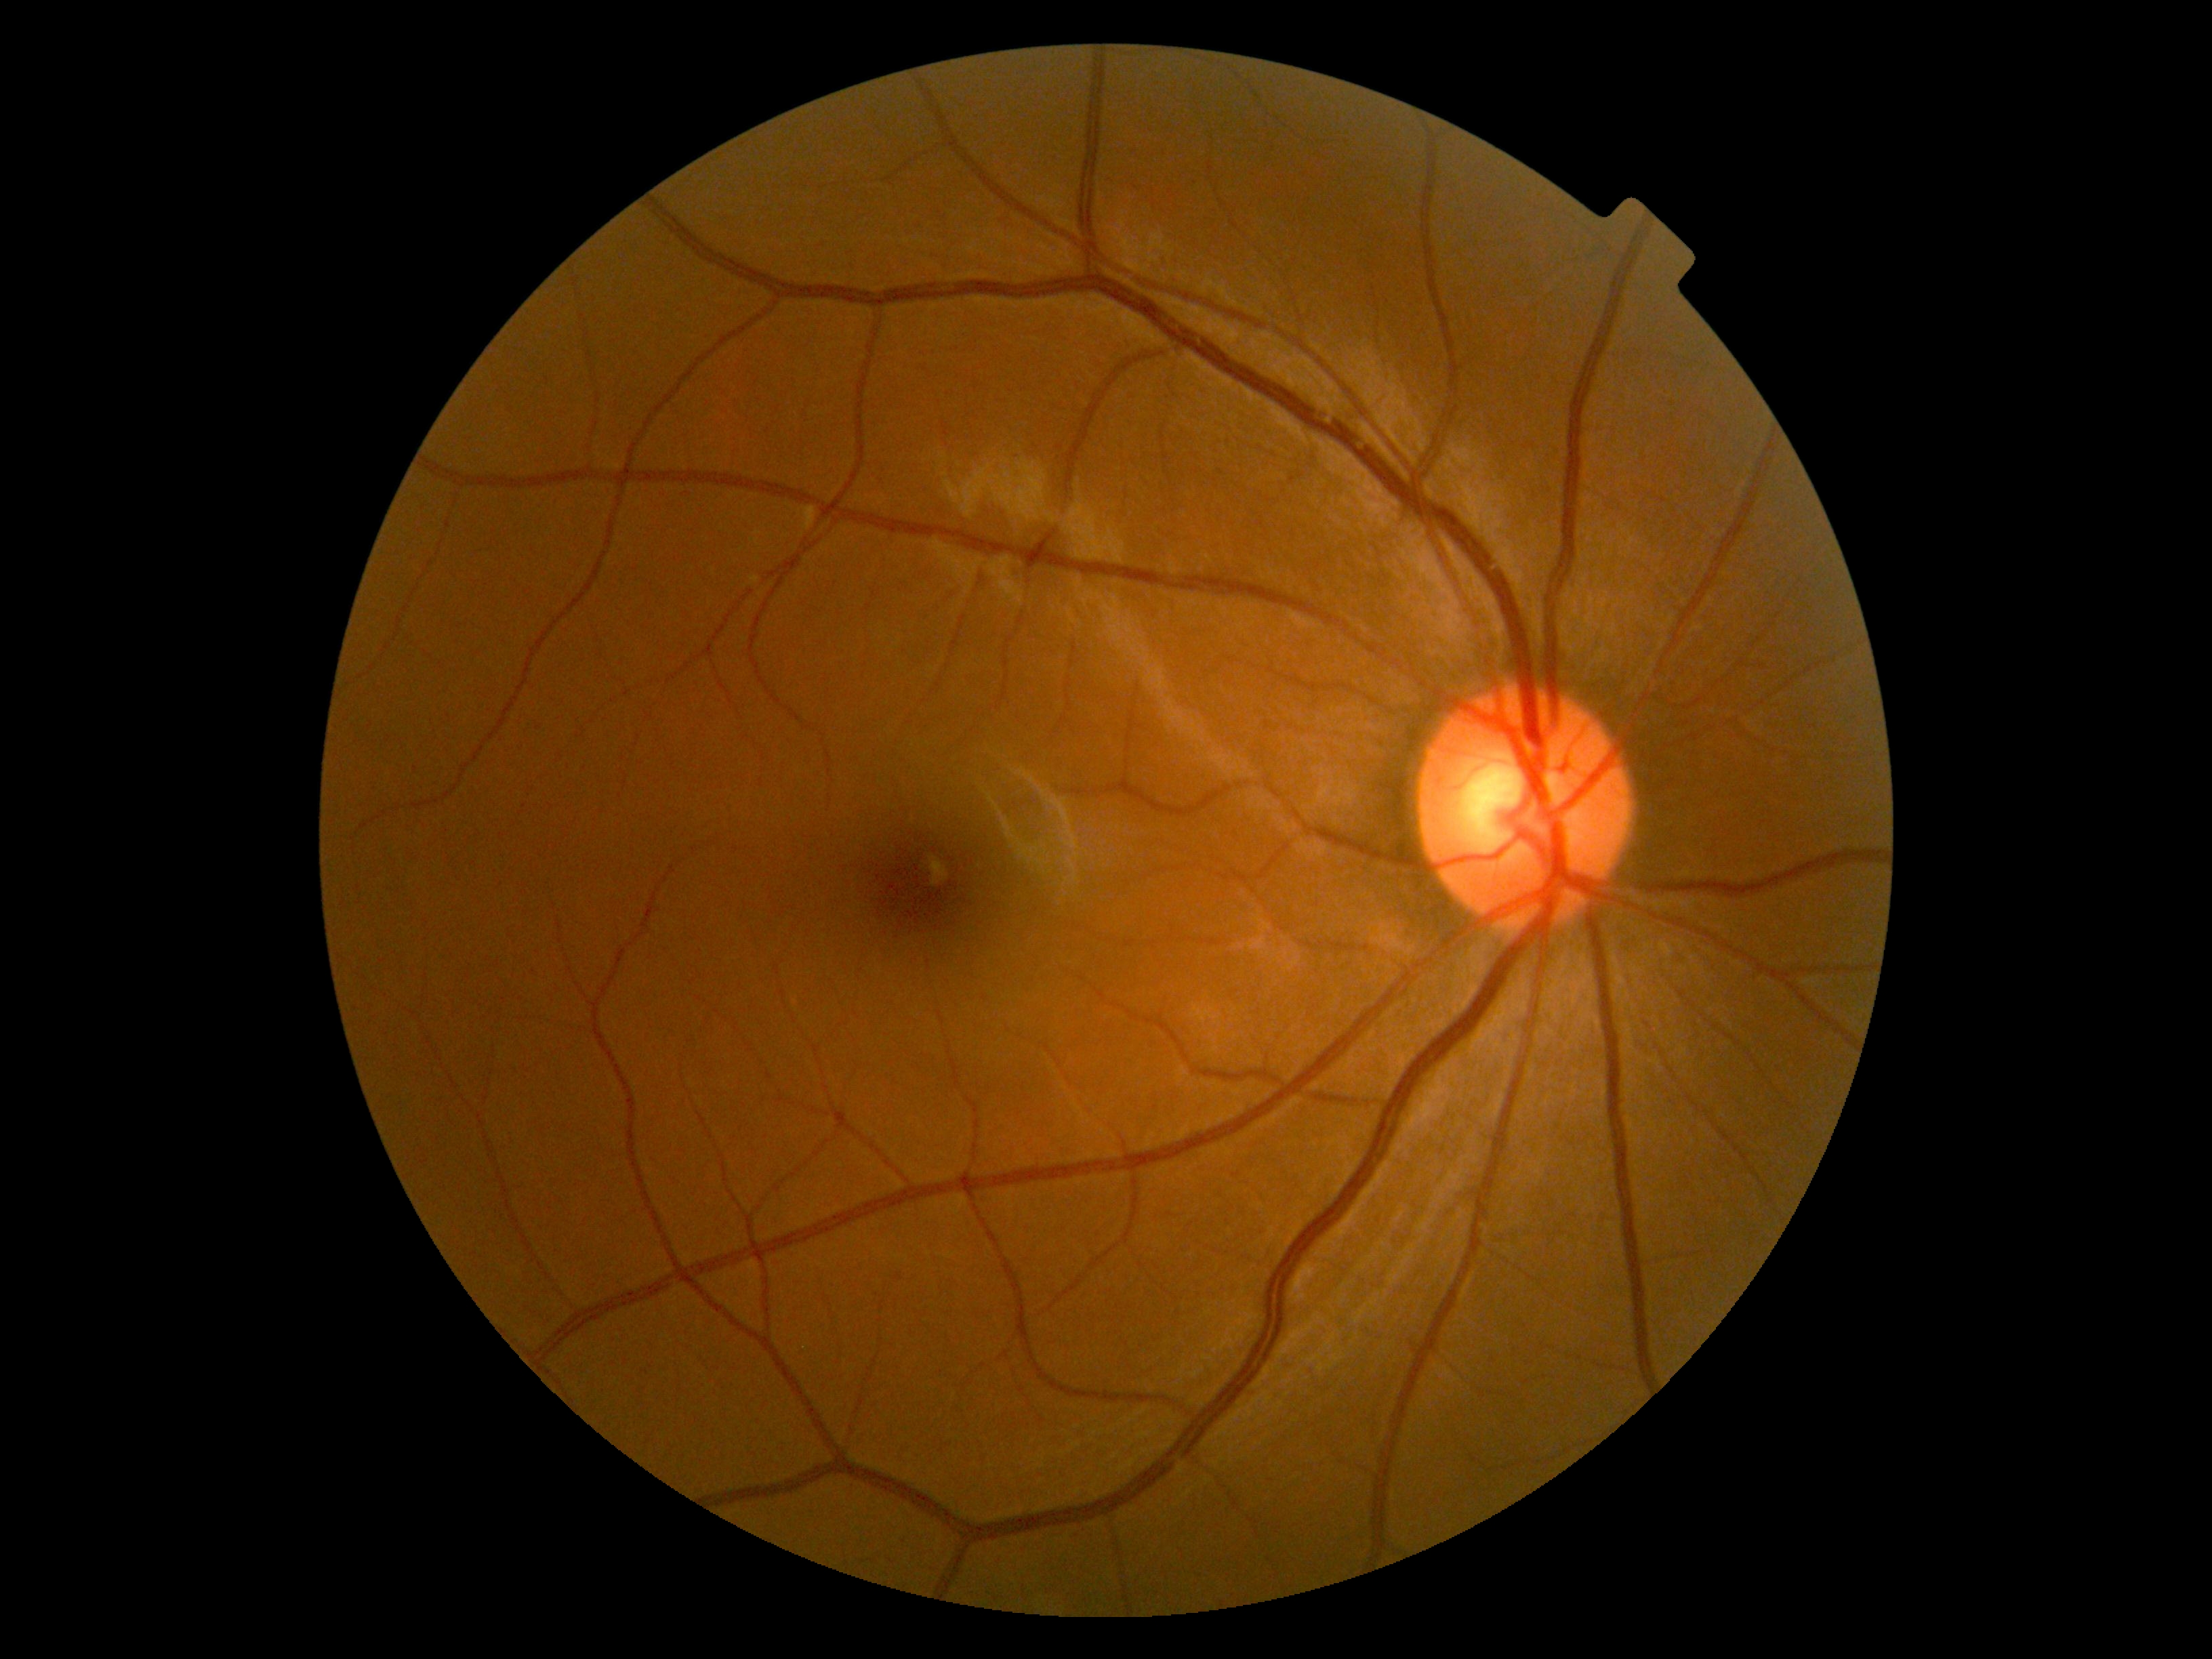 DR grade is no apparent retinopathy (0).